No pharmacologic dilation · 45 degree fundus photograph — 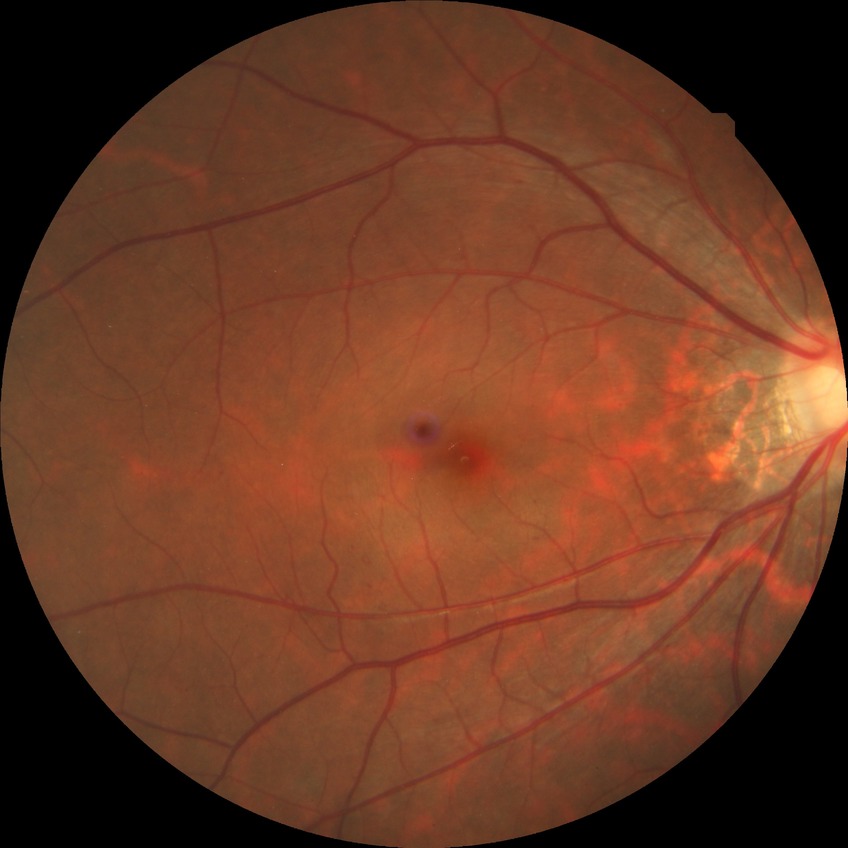

Modified Davis classification is simple diabetic retinopathy.